Wide-field fundus photograph of an infant; 640x480px
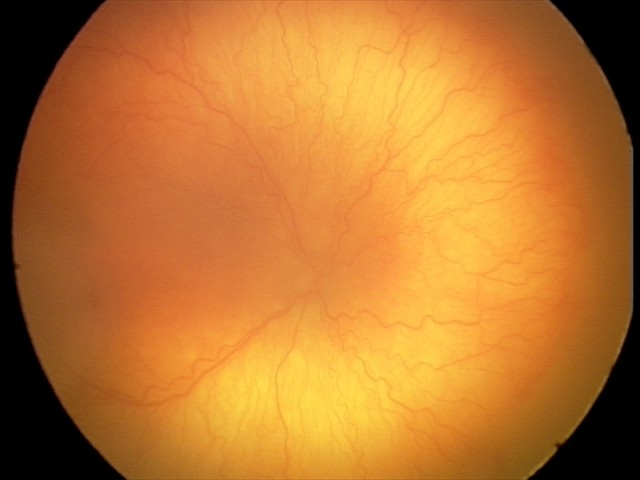 From an examination with diagnosis of aggressive retinopathy of prematurity (A-ROP). Plus disease was diagnosed.